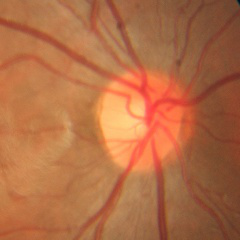
Glaucoma status = no glaucomatous findings.